Color fundus image: 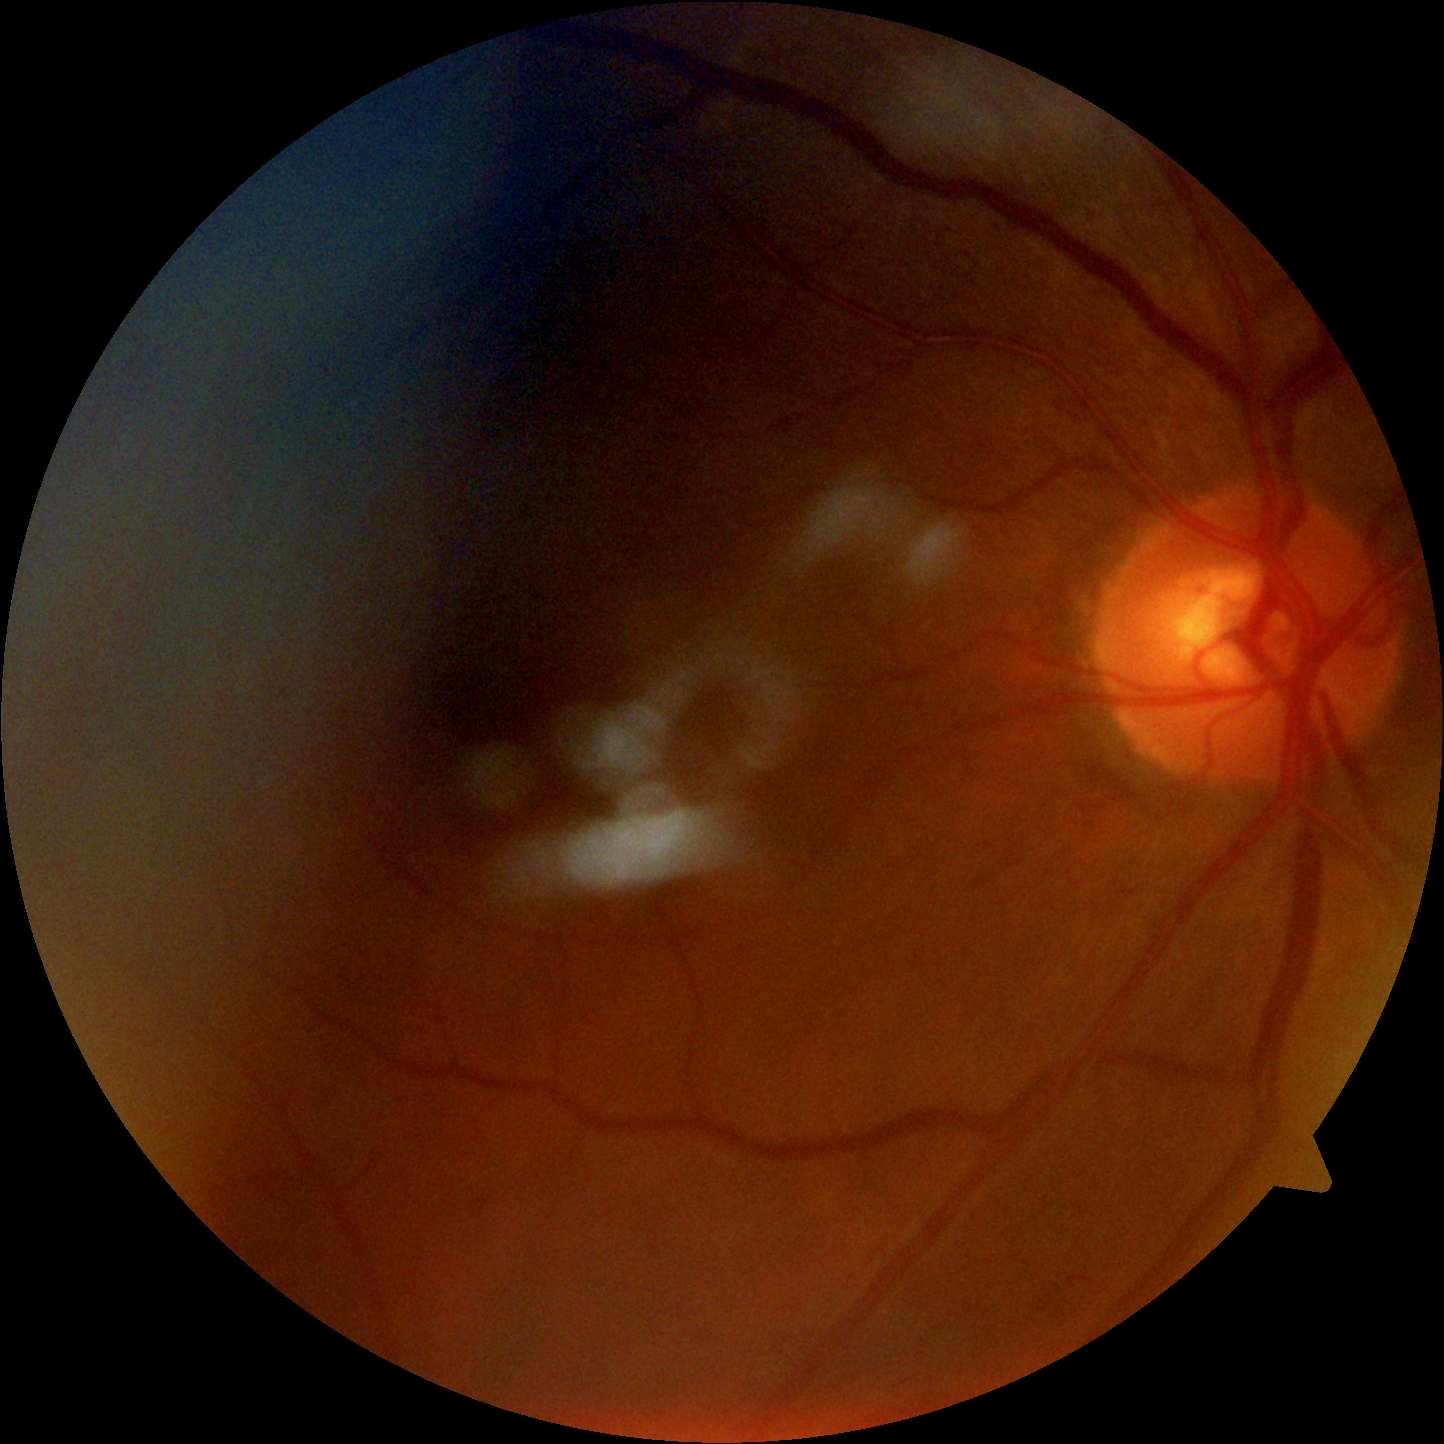
DR impression: negative for DR | retinopathy grade: 0 (no apparent retinopathy).